Posterior pole photograph: 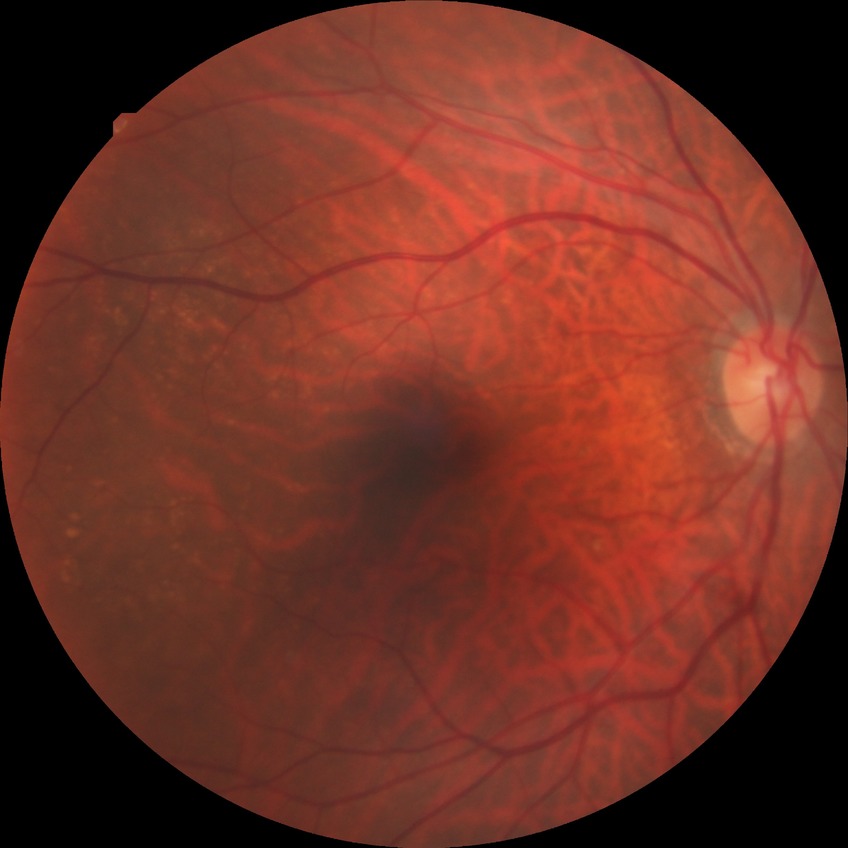
Assessment:
- Davis grade — NDR